Fundus photograph cropped around the optic nerve head — 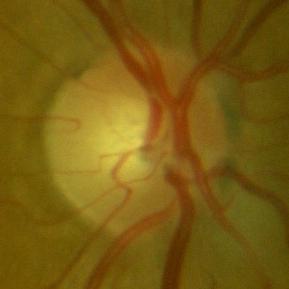 Assessment: no signs of glaucoma.